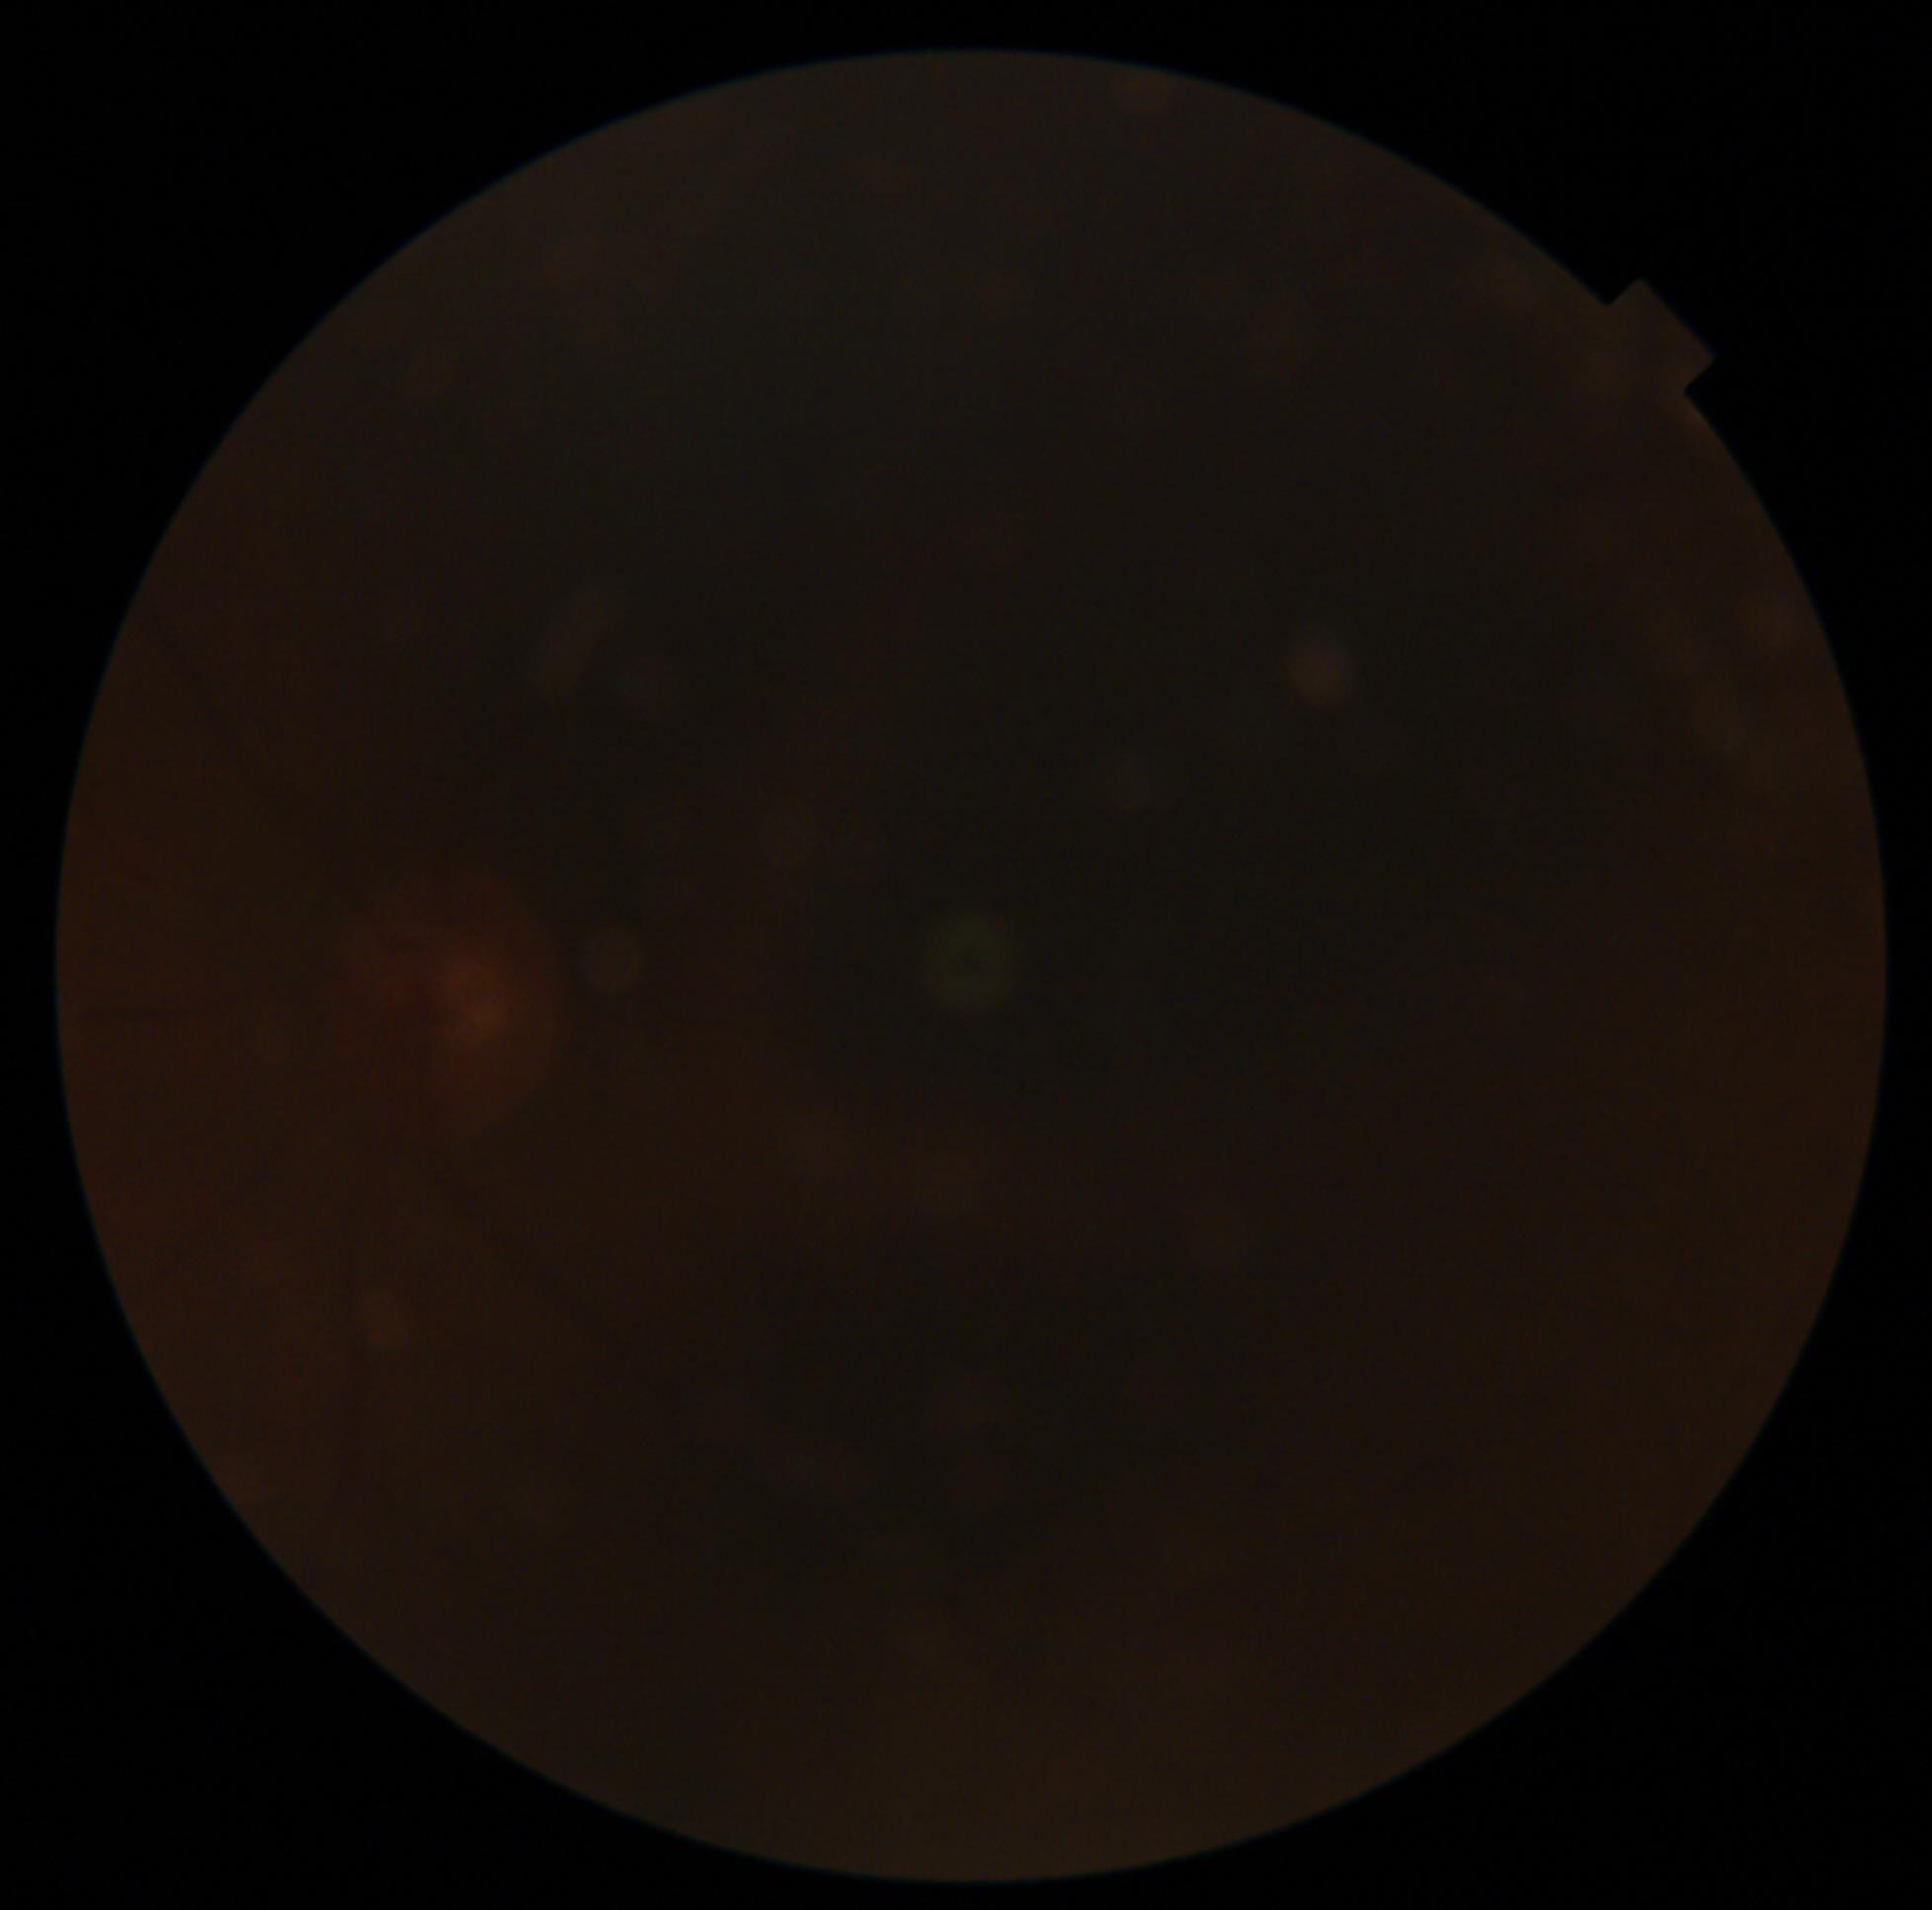 Retinopathy grade: ungradable.